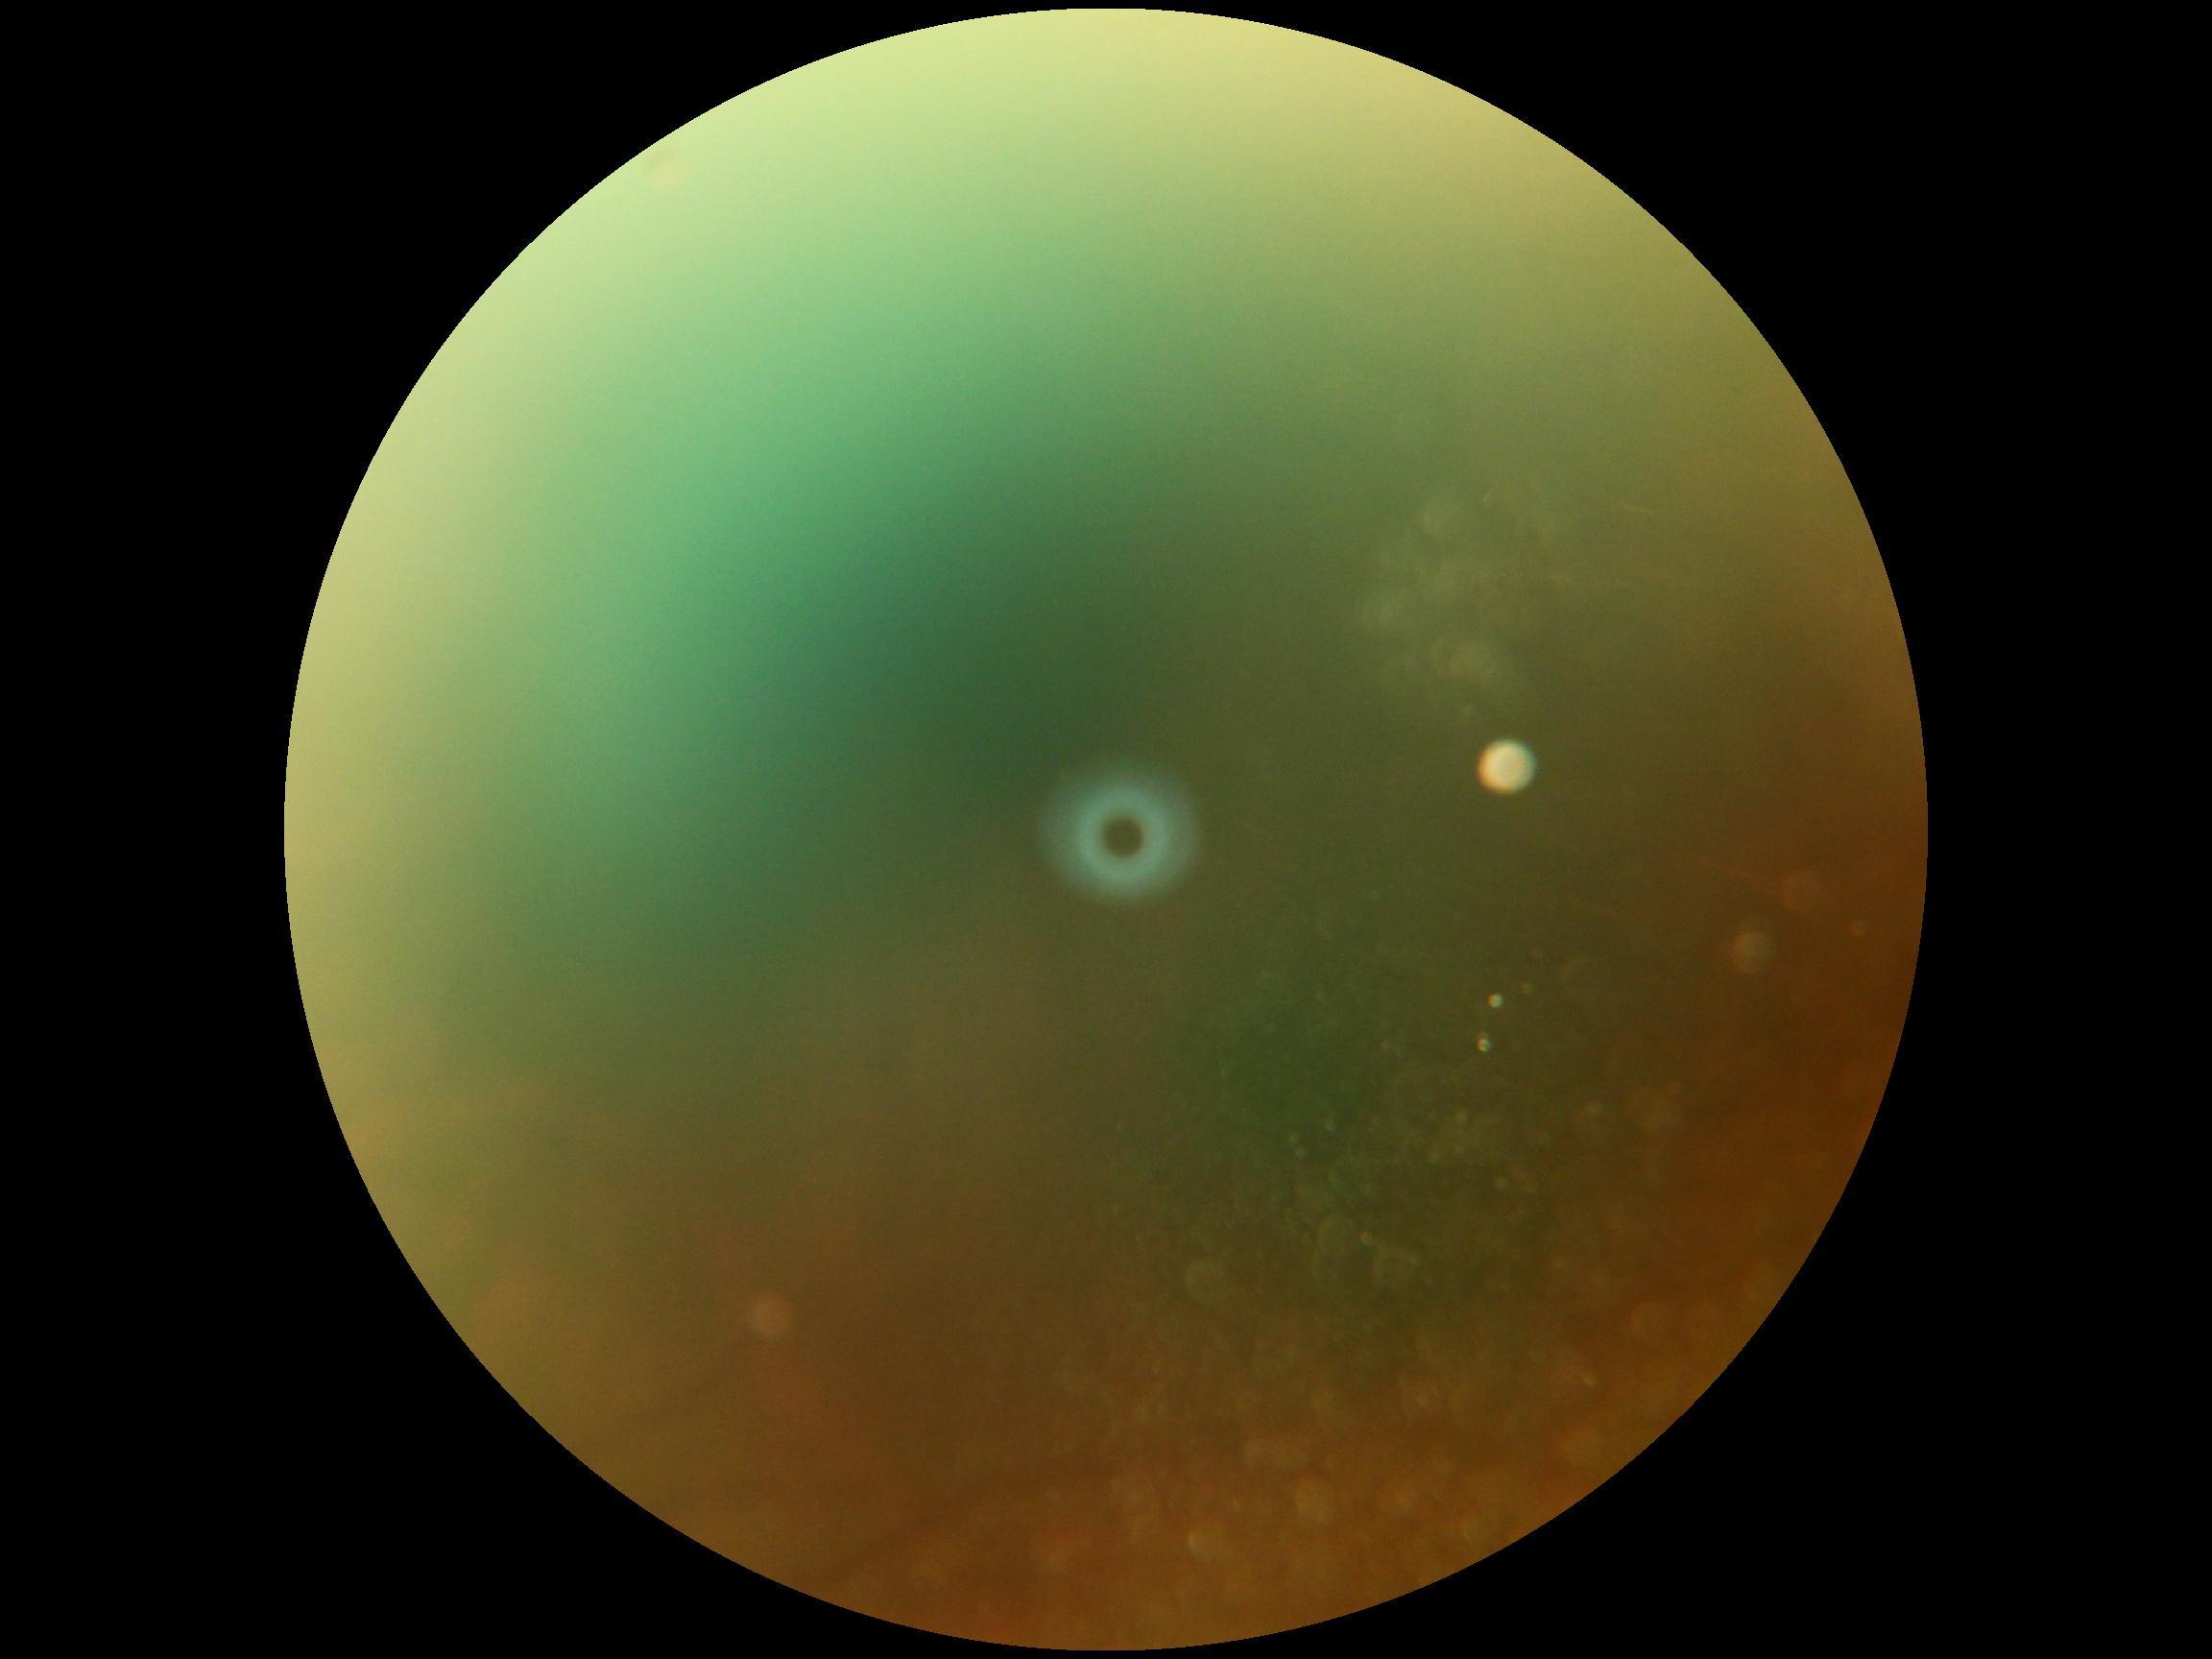
DR severity is ungradable.